NIDEK AFC-230: 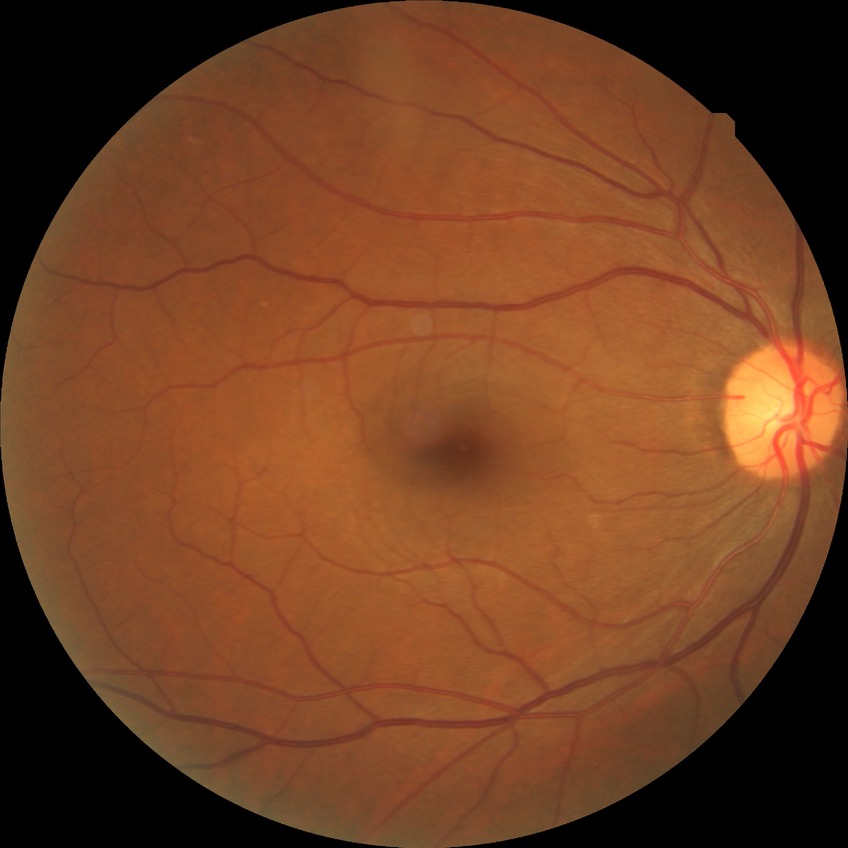 DR: NDR. No diabetic retinal disease findings.